Posterior pole photograph; 848 x 848 pixels; Davis DR grading — 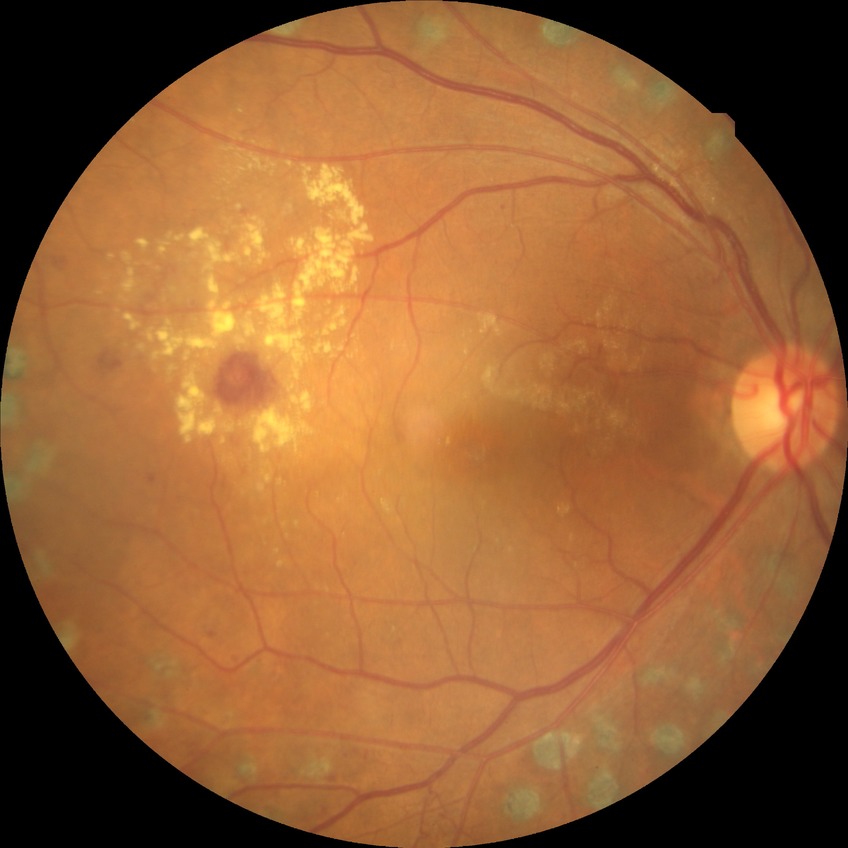

Diabetic retinopathy severity: proliferative diabetic retinopathy.